848 x 848 pixels:
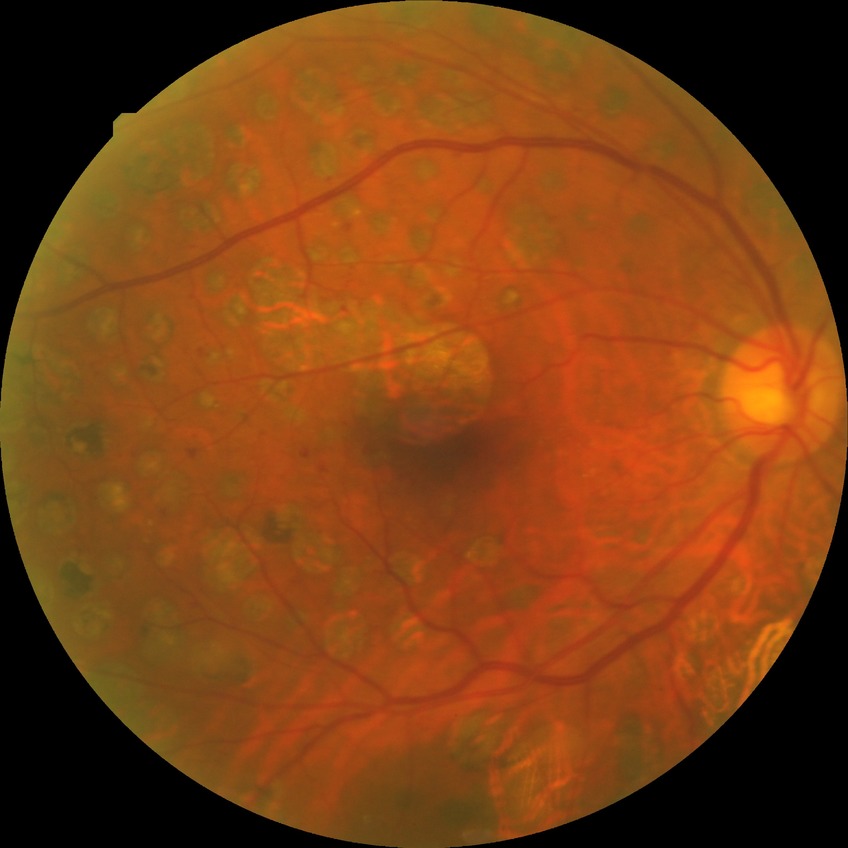

DR severity@PDR.